2352 x 1568 pixels; CFP; 45° field of view
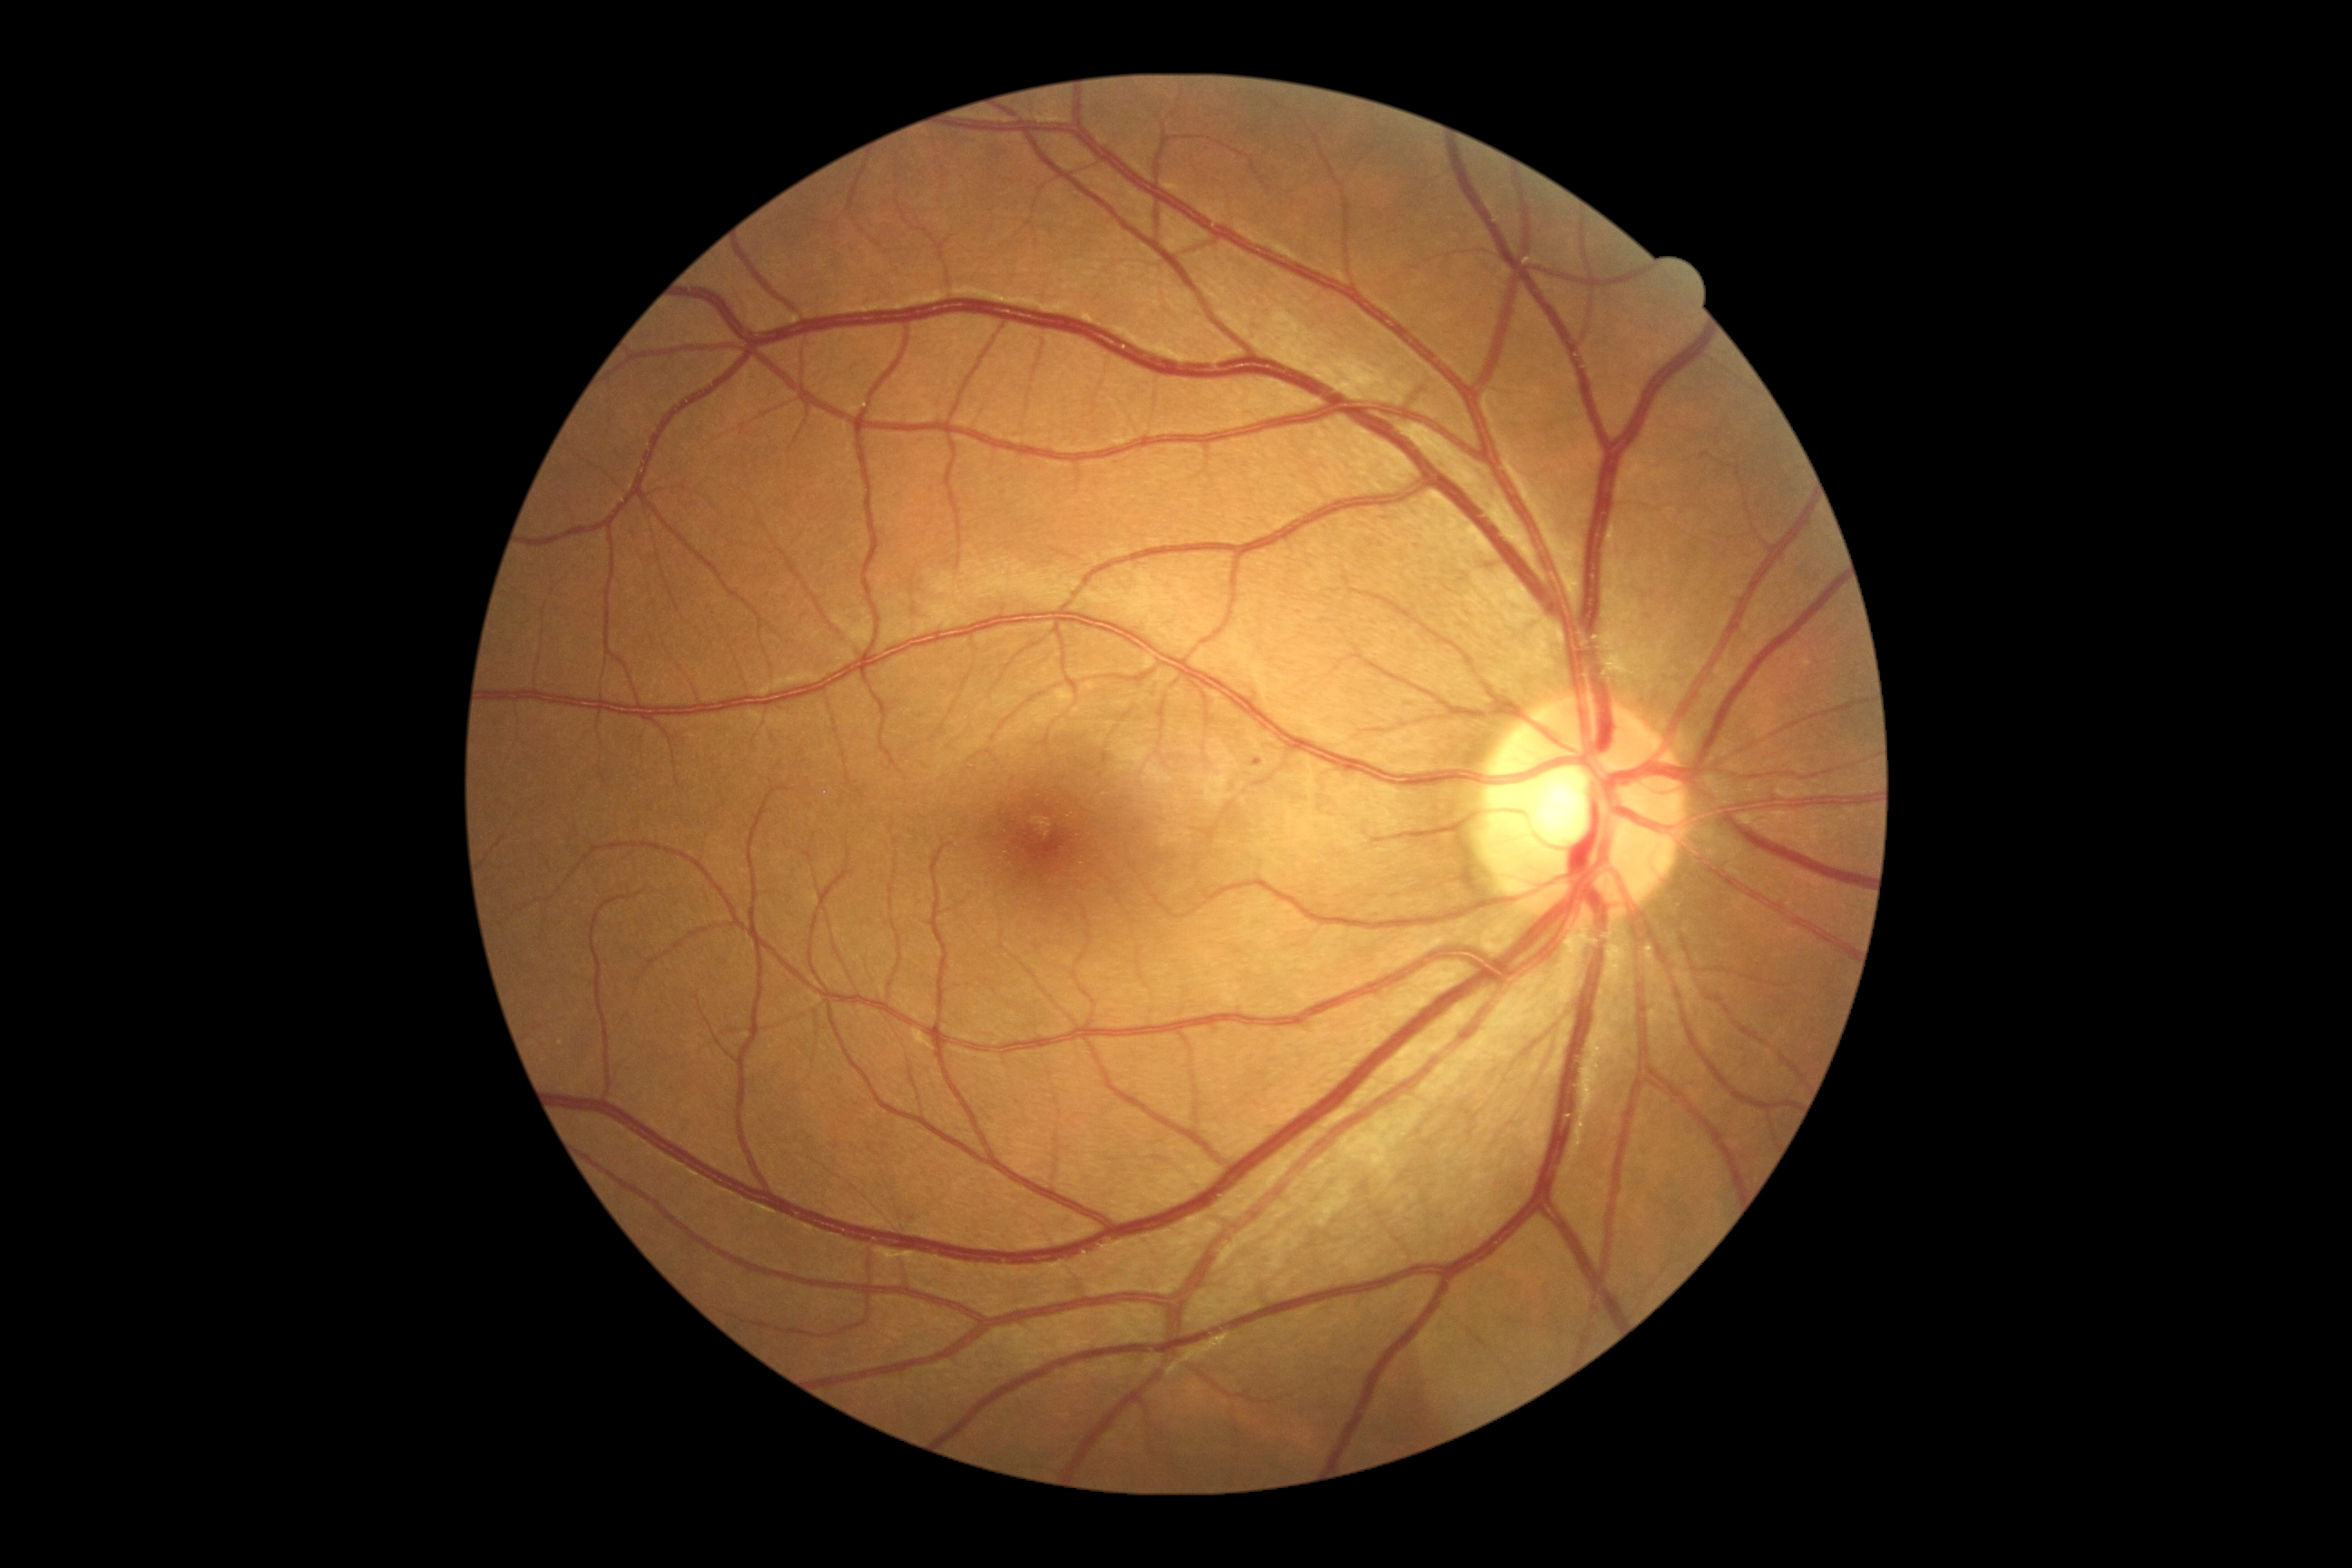

dr_grade: 1
lesions:
  se: []
  he: []
  ma:
    - rect(1253, 760, 1262, 767)
  ex: []